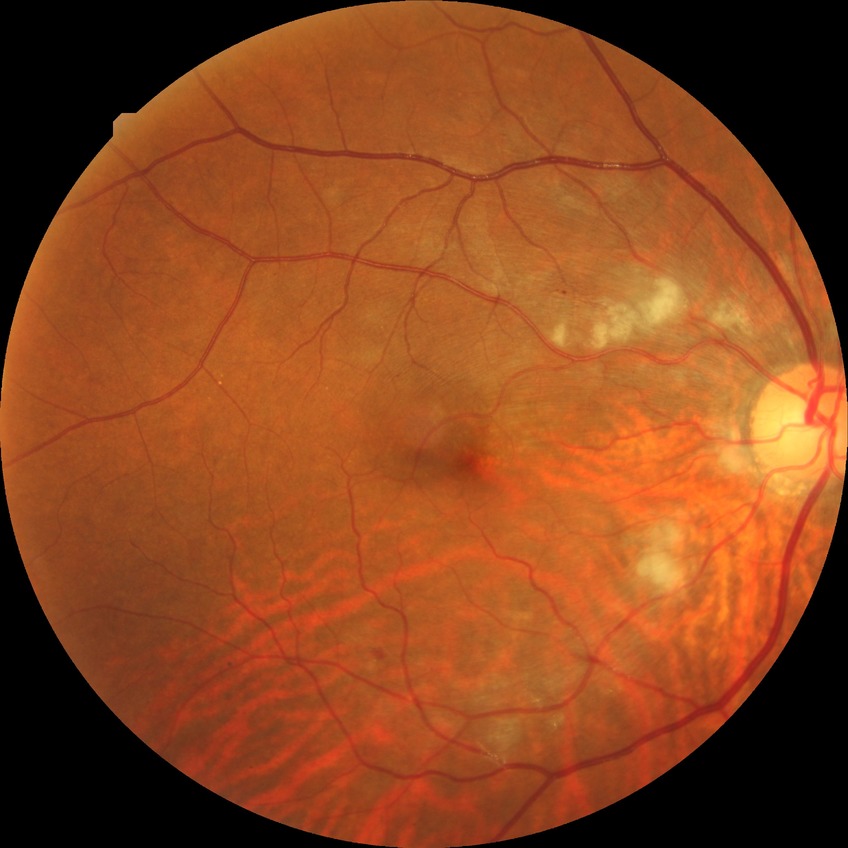
Diabetic retinopathy (DR): PPDR (pre-proliferative diabetic retinopathy).